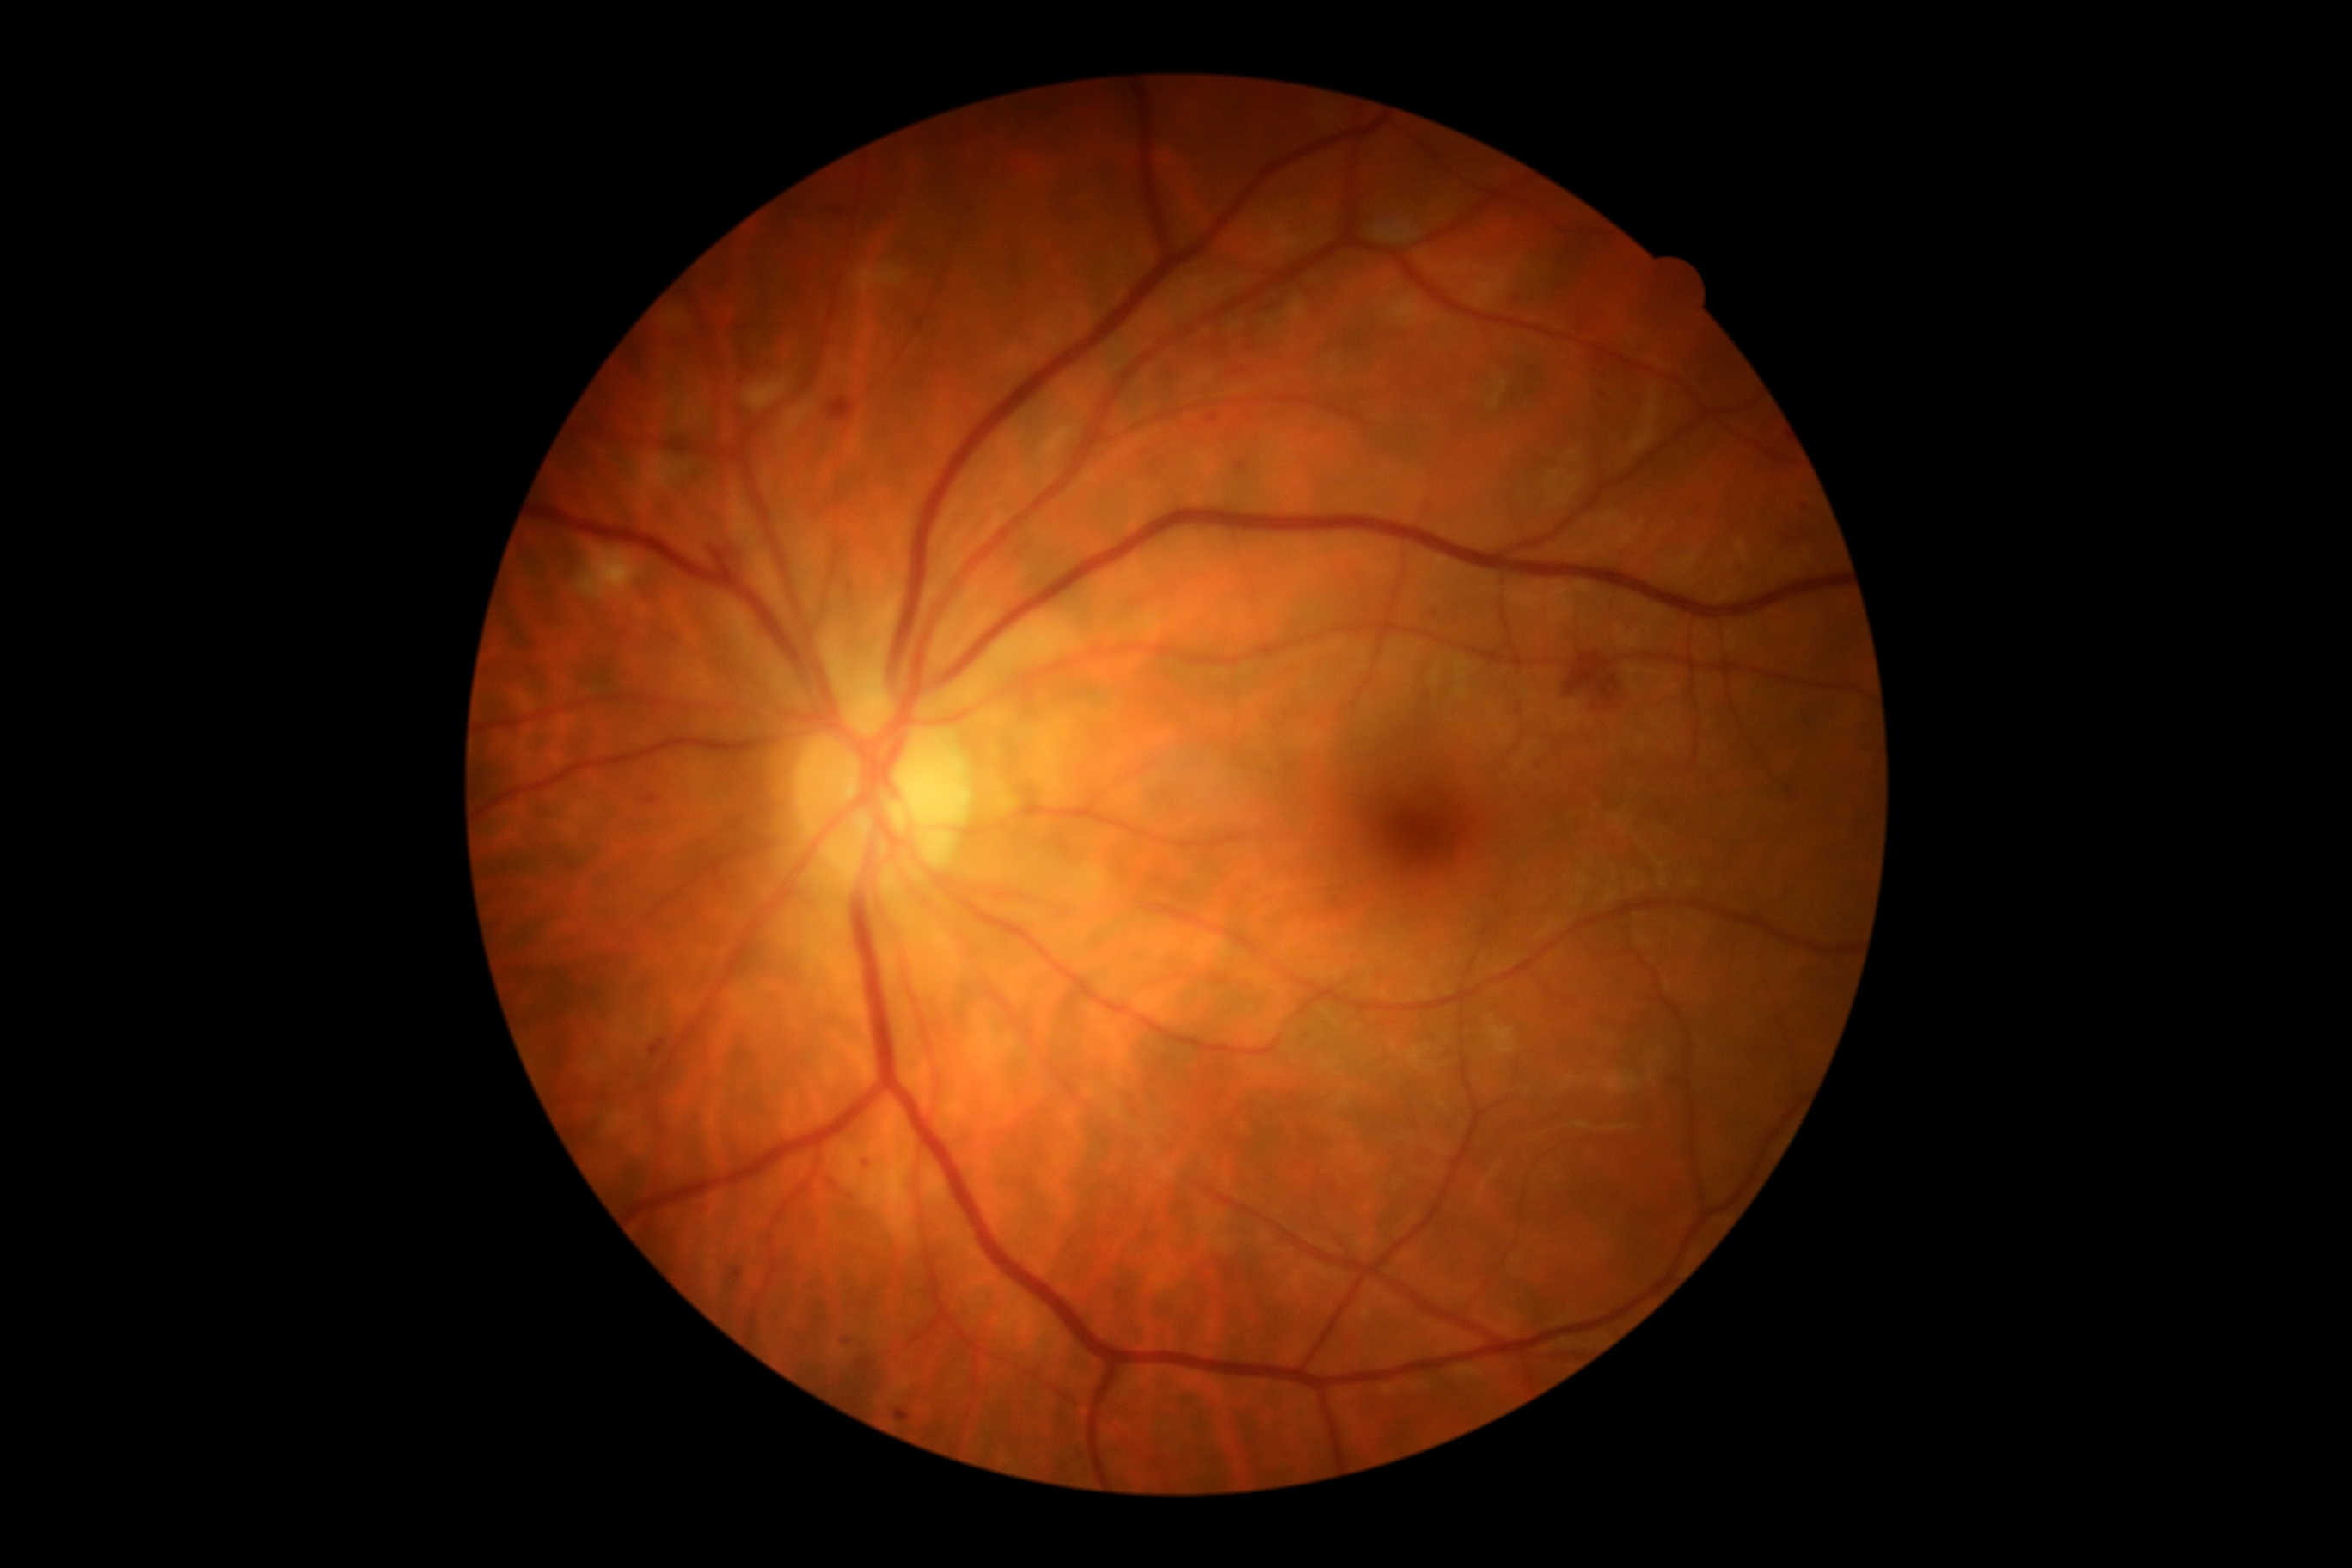

dr_grade: 2